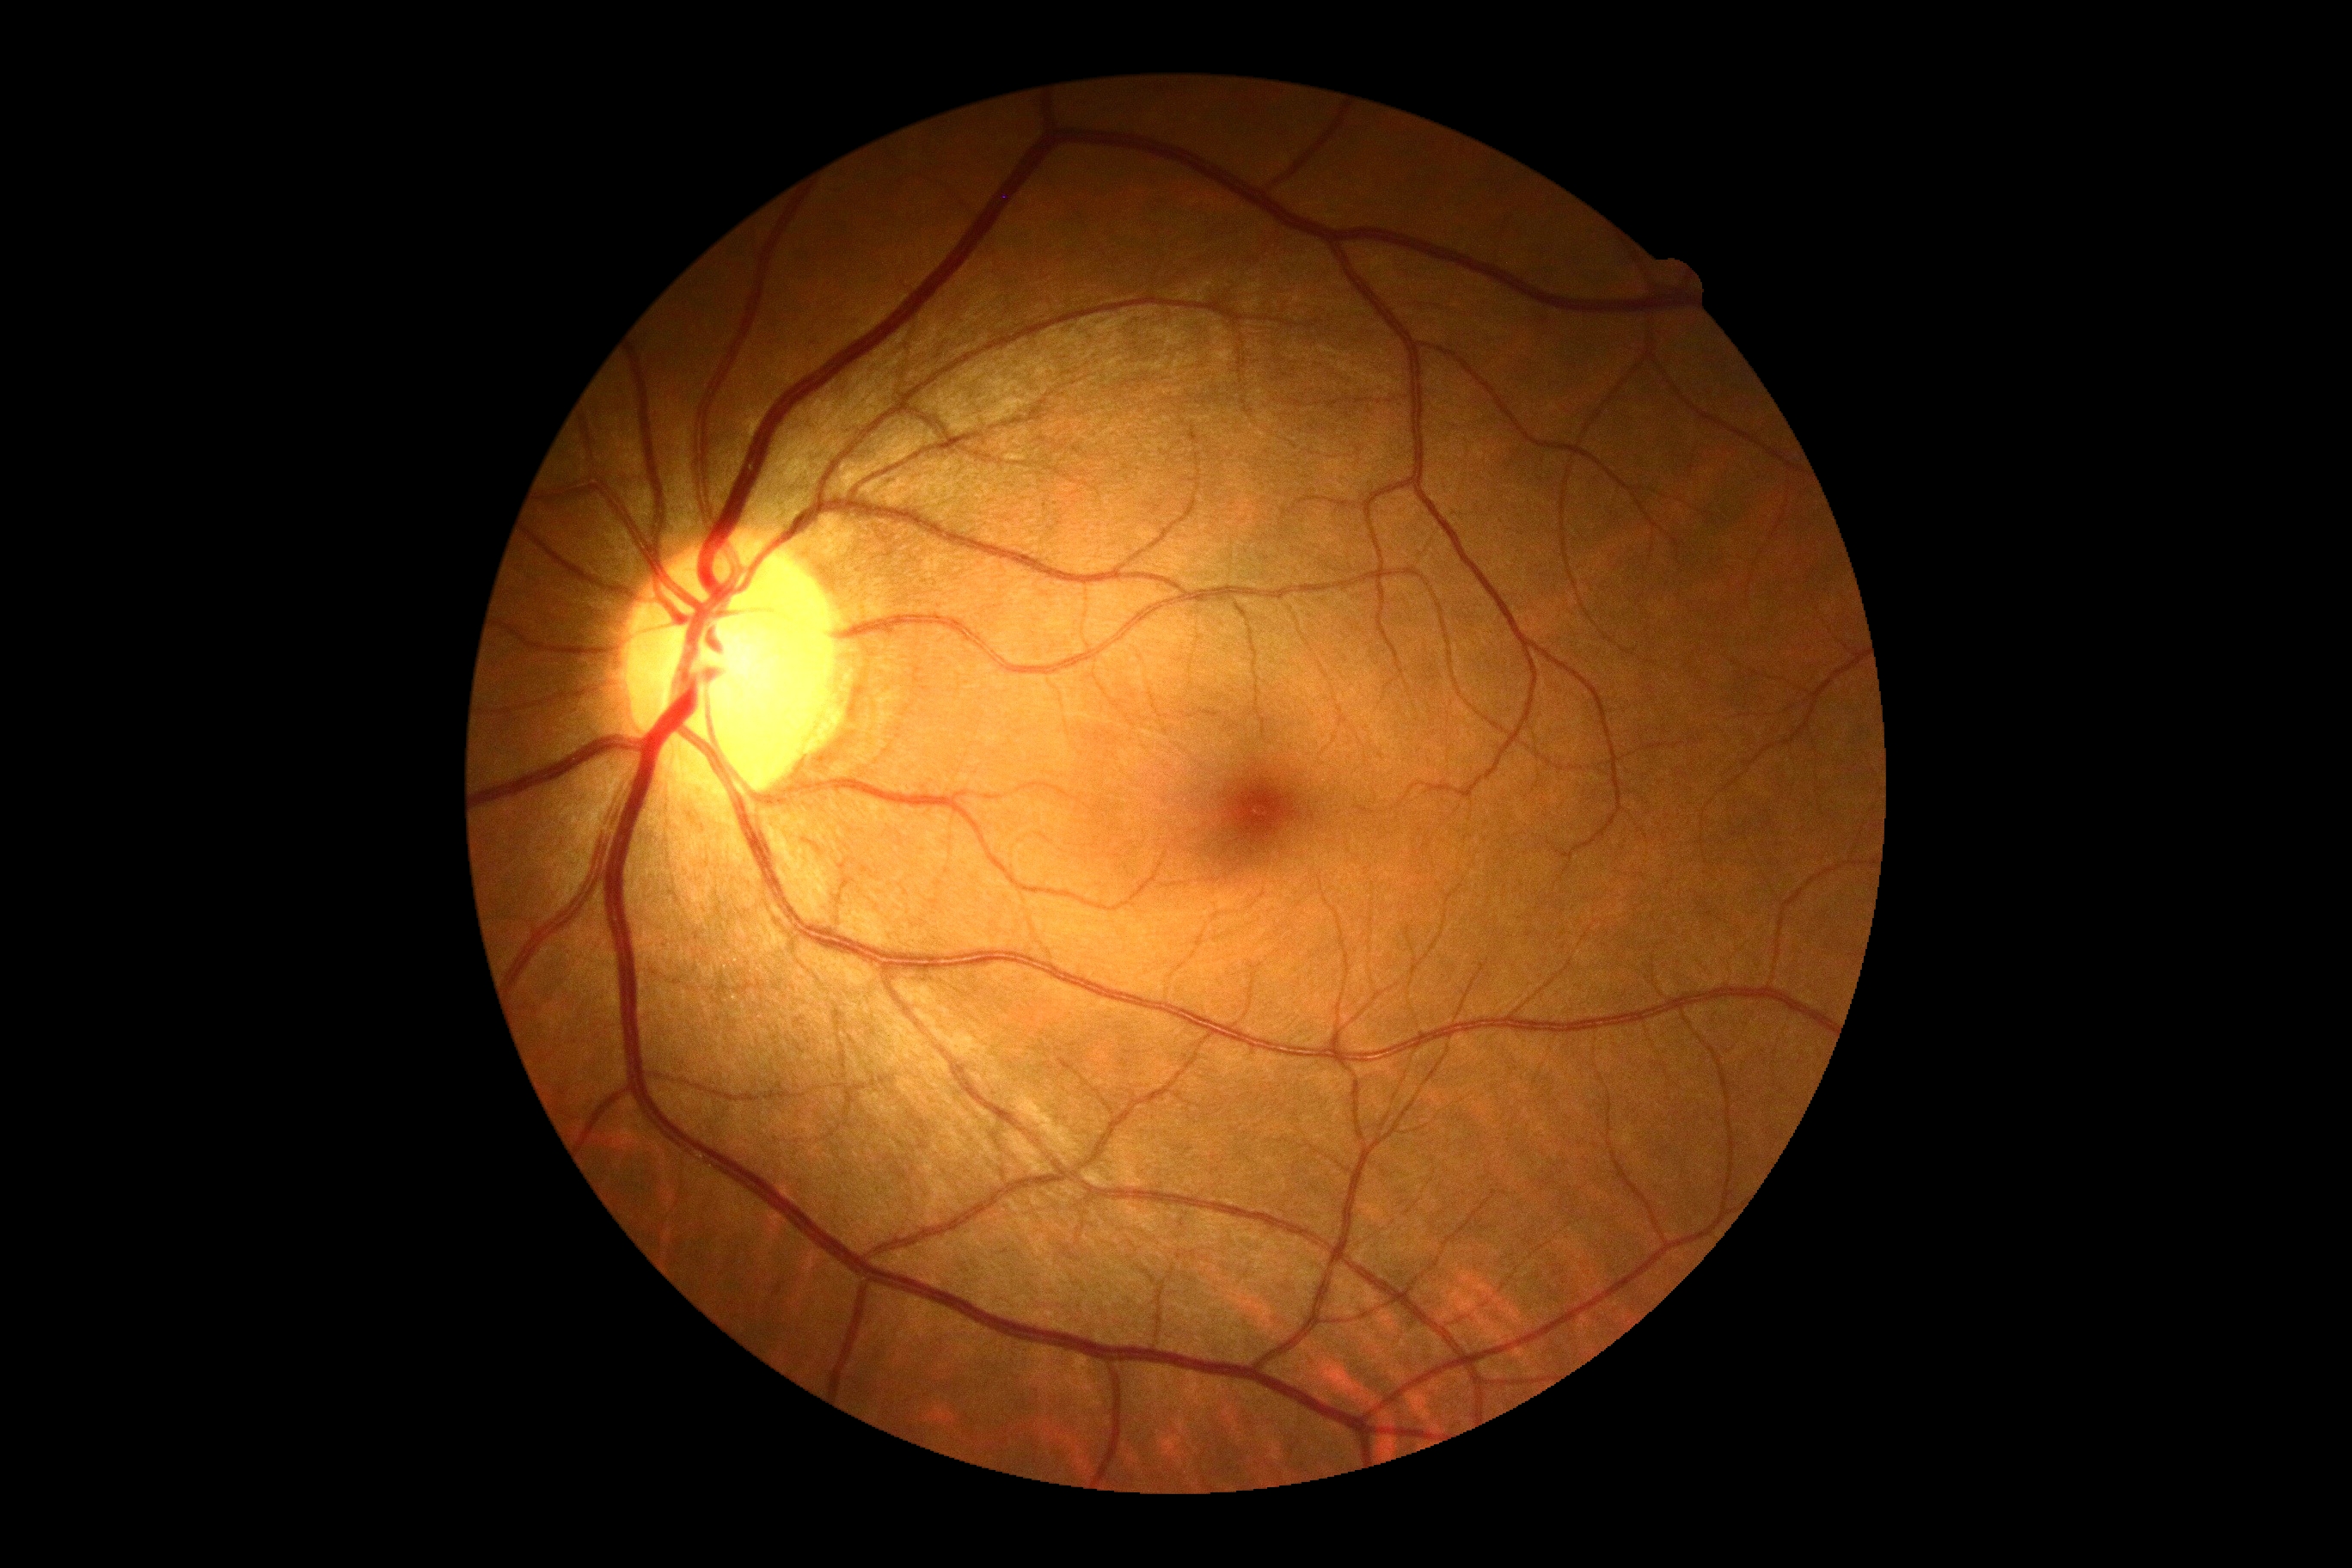

DR severity: grade 0. No signs of diabetic retinopathy.